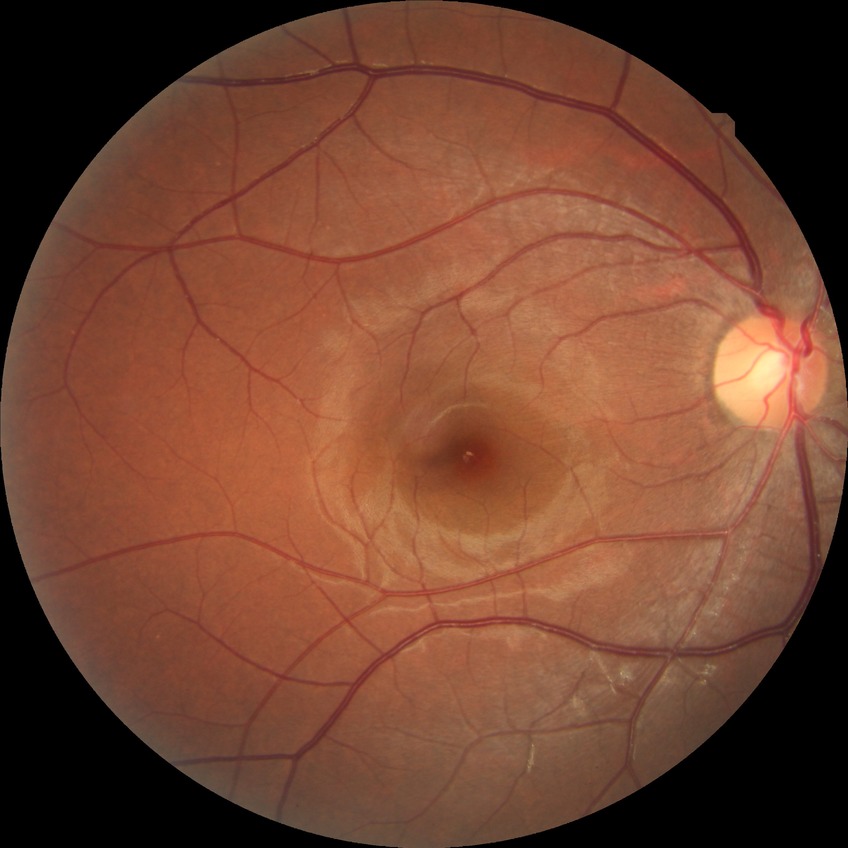 diabetic retinopathy (DR): NDR (no diabetic retinopathy).